Wide-field fundus photograph from neonatal ROP screening — 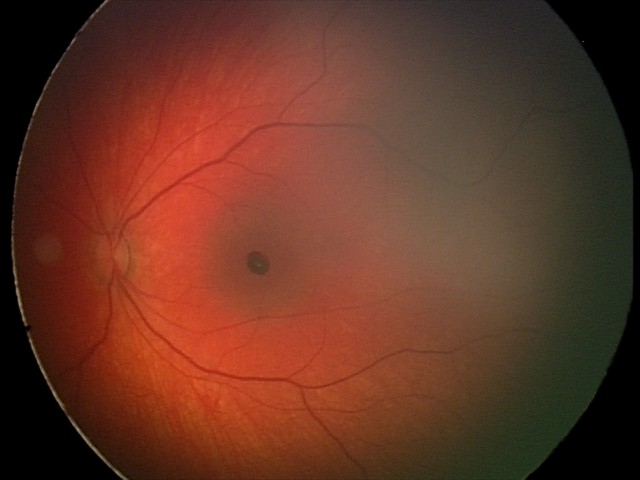
Screening diagnosis: retinal hemorrhages.